Image size 2212x1659 · color fundus photograph · 45° field of view.
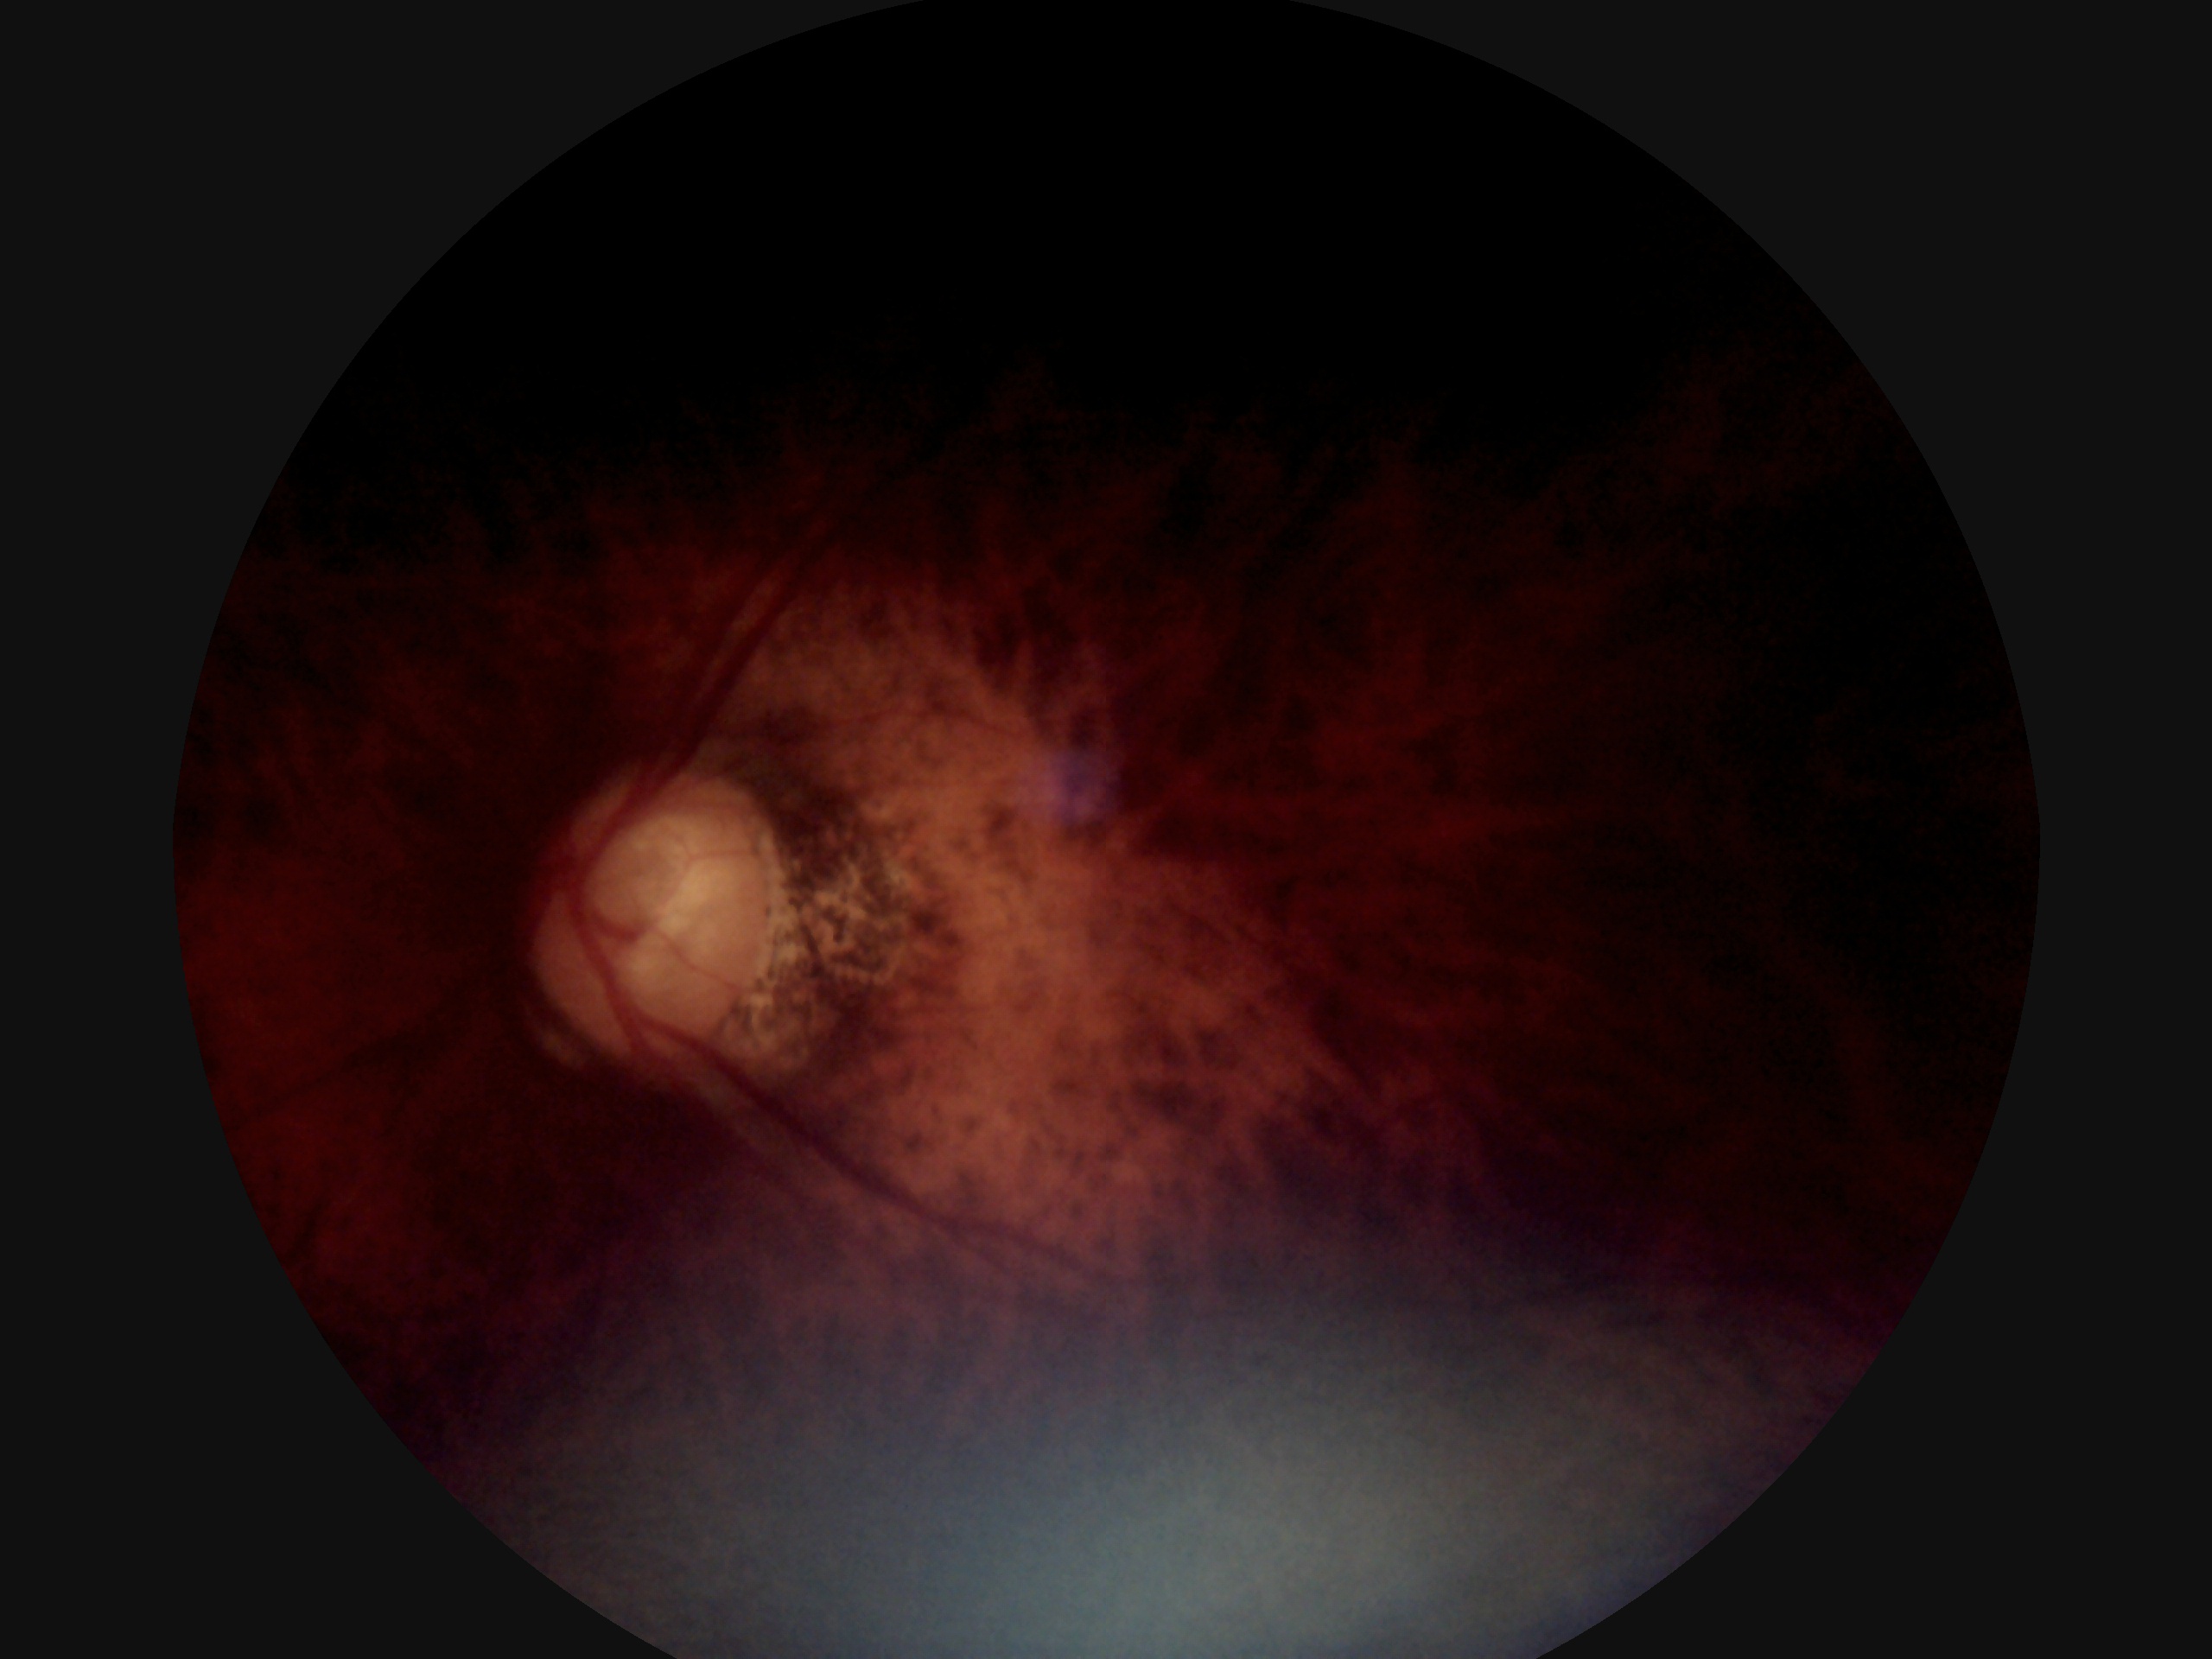 diabetic retinopathy (DR): ungradable.